2048x1536px: 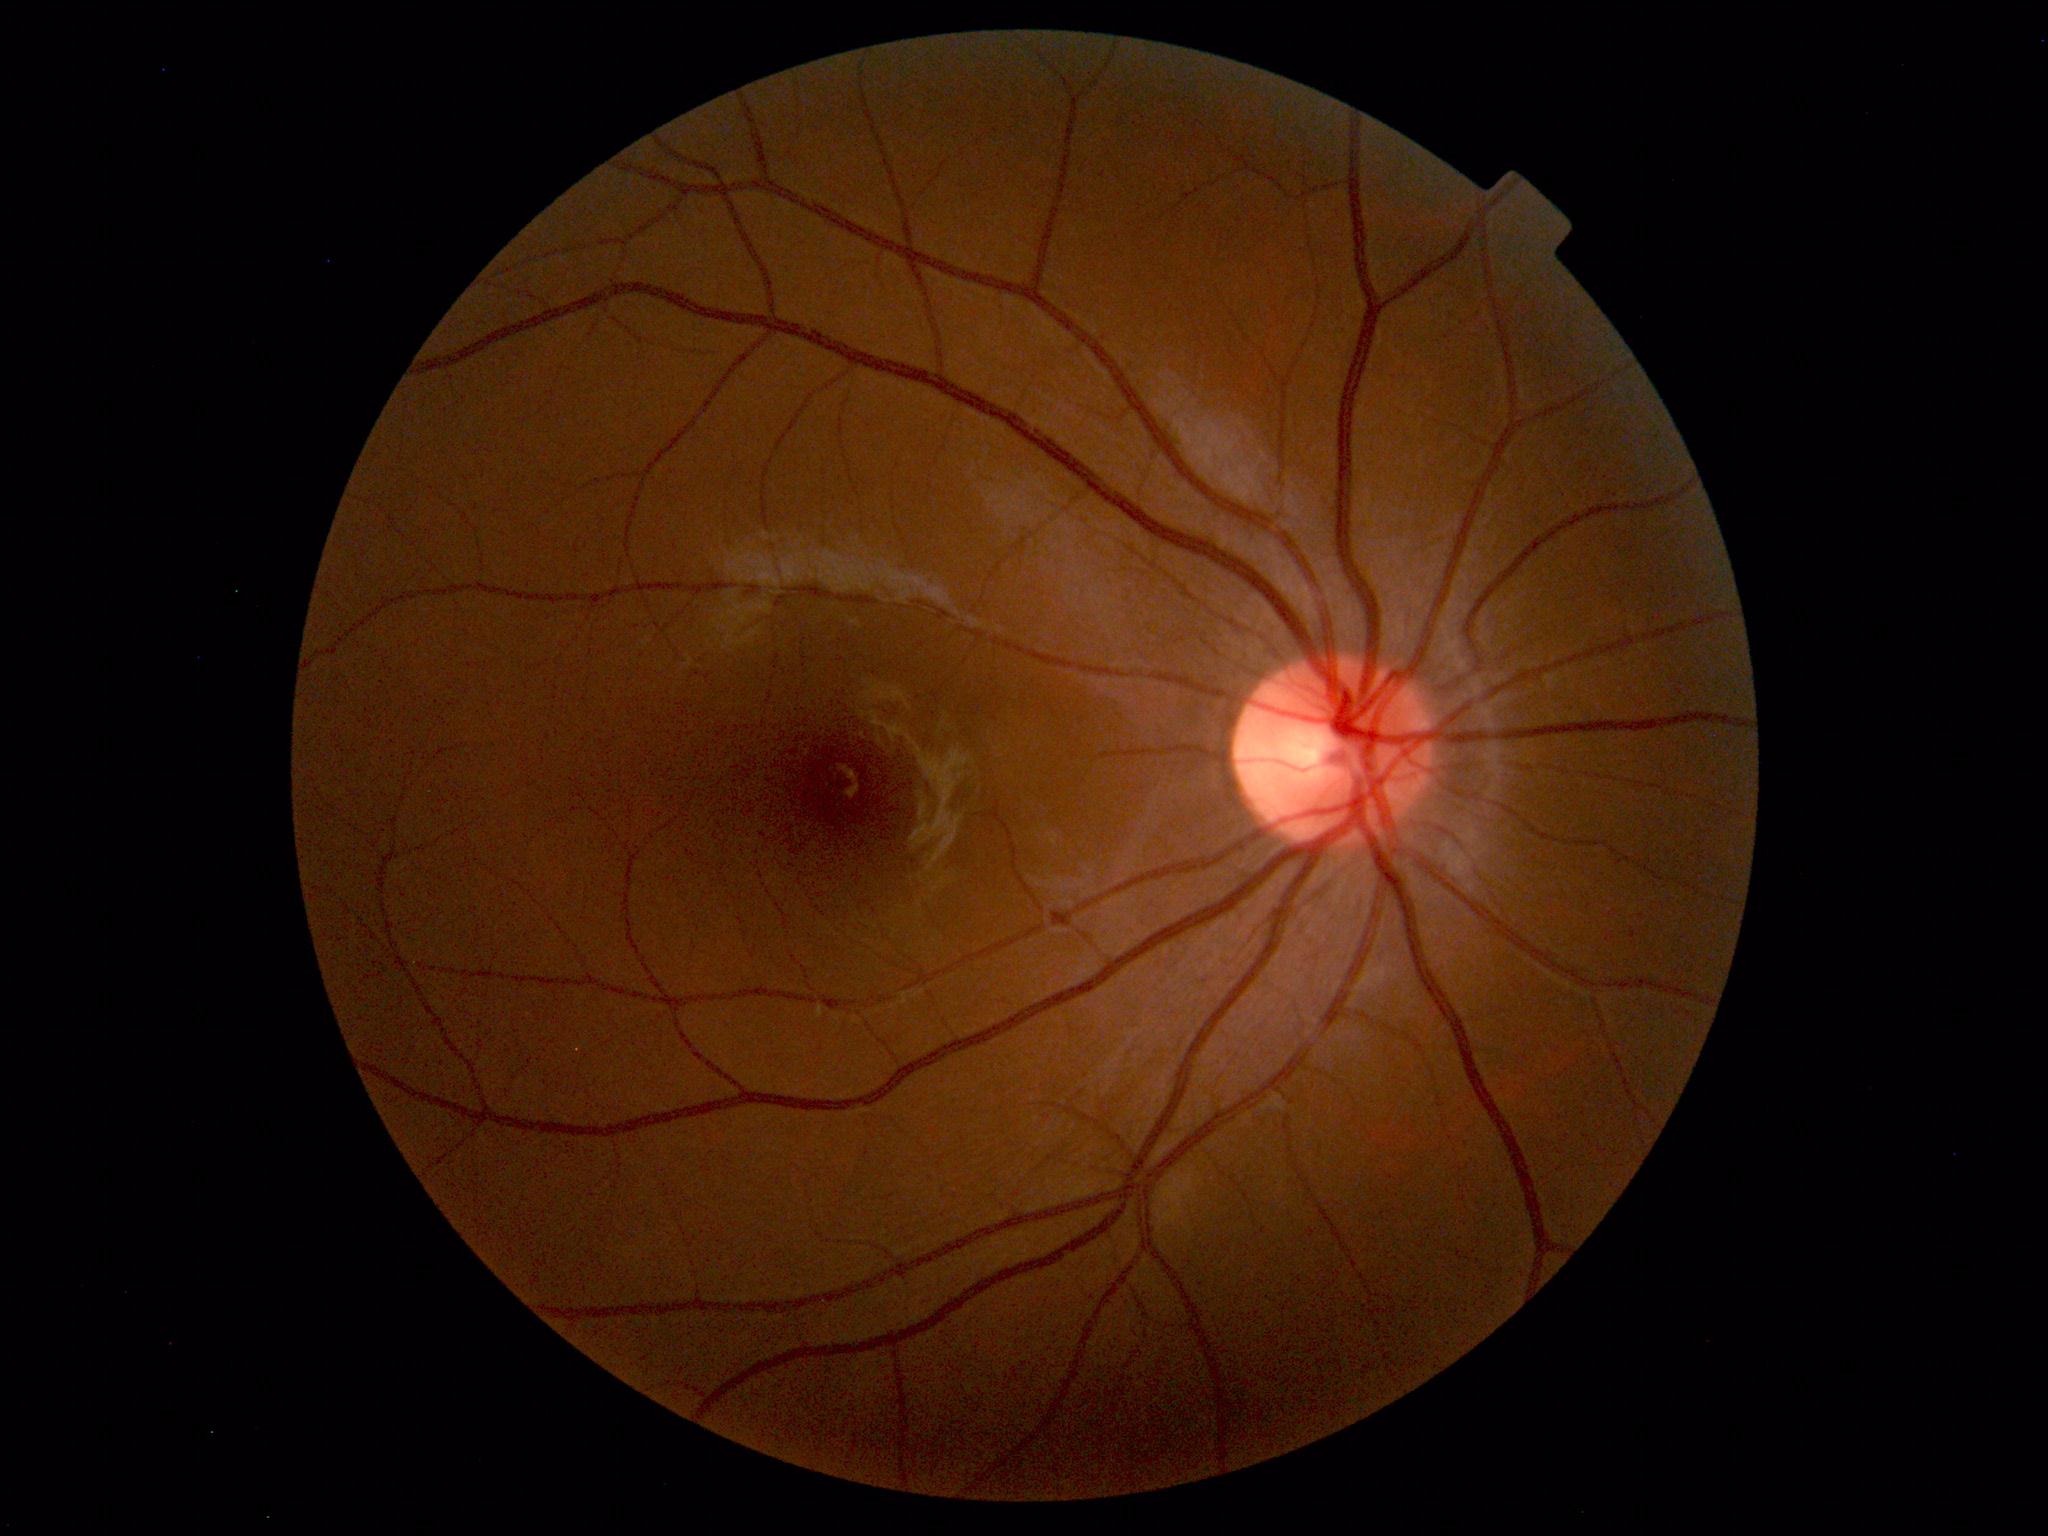 Impression: normal fundus.